Davis DR grading
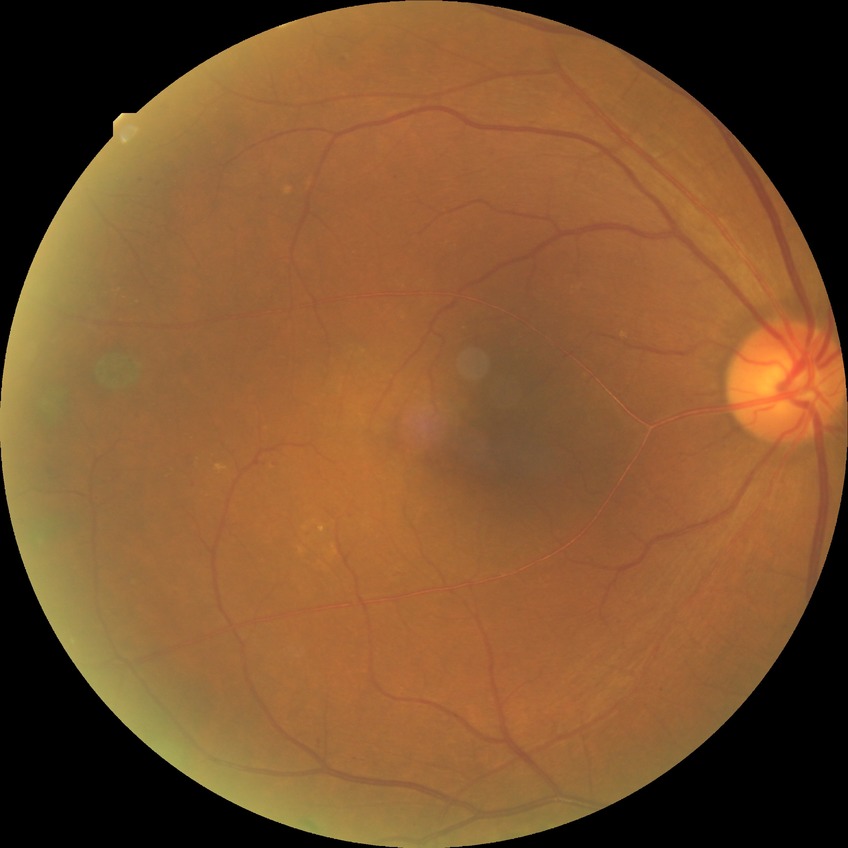

diabetic retinopathy (DR): proliferative diabetic retinopathy (PDR).